50° field of view; fundus photo — 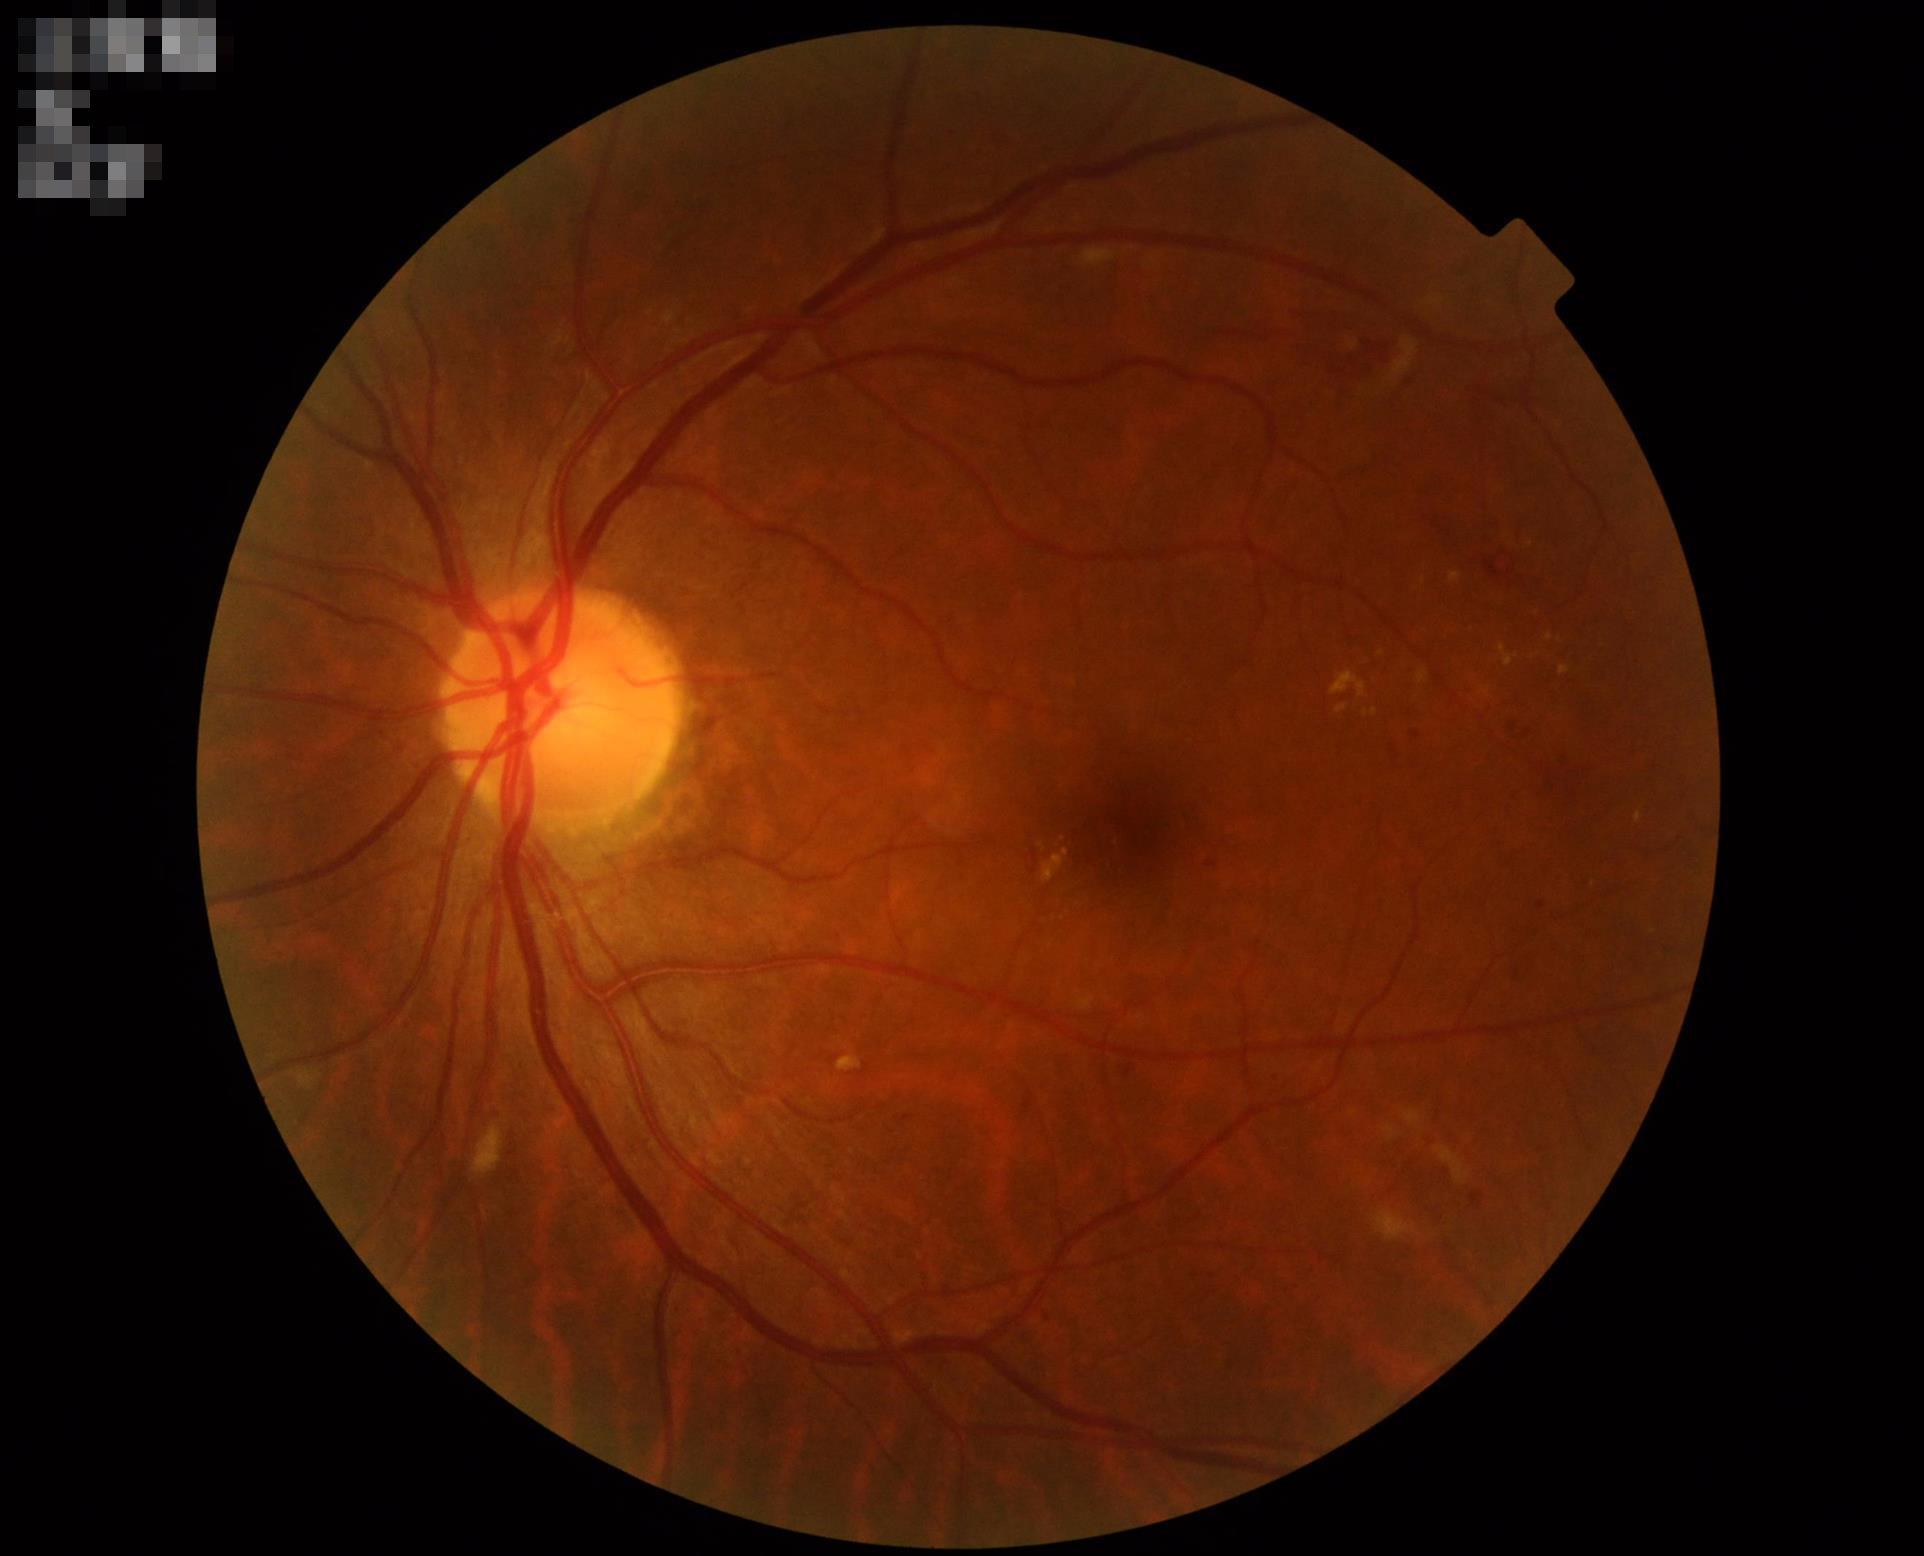 Overall quality = good, gradable
Contrast = good dynamic range
Focus = sharp throughout the field
Illumination = even and well-balanced